2048 by 1536 pixels; FOV: 45 degrees: 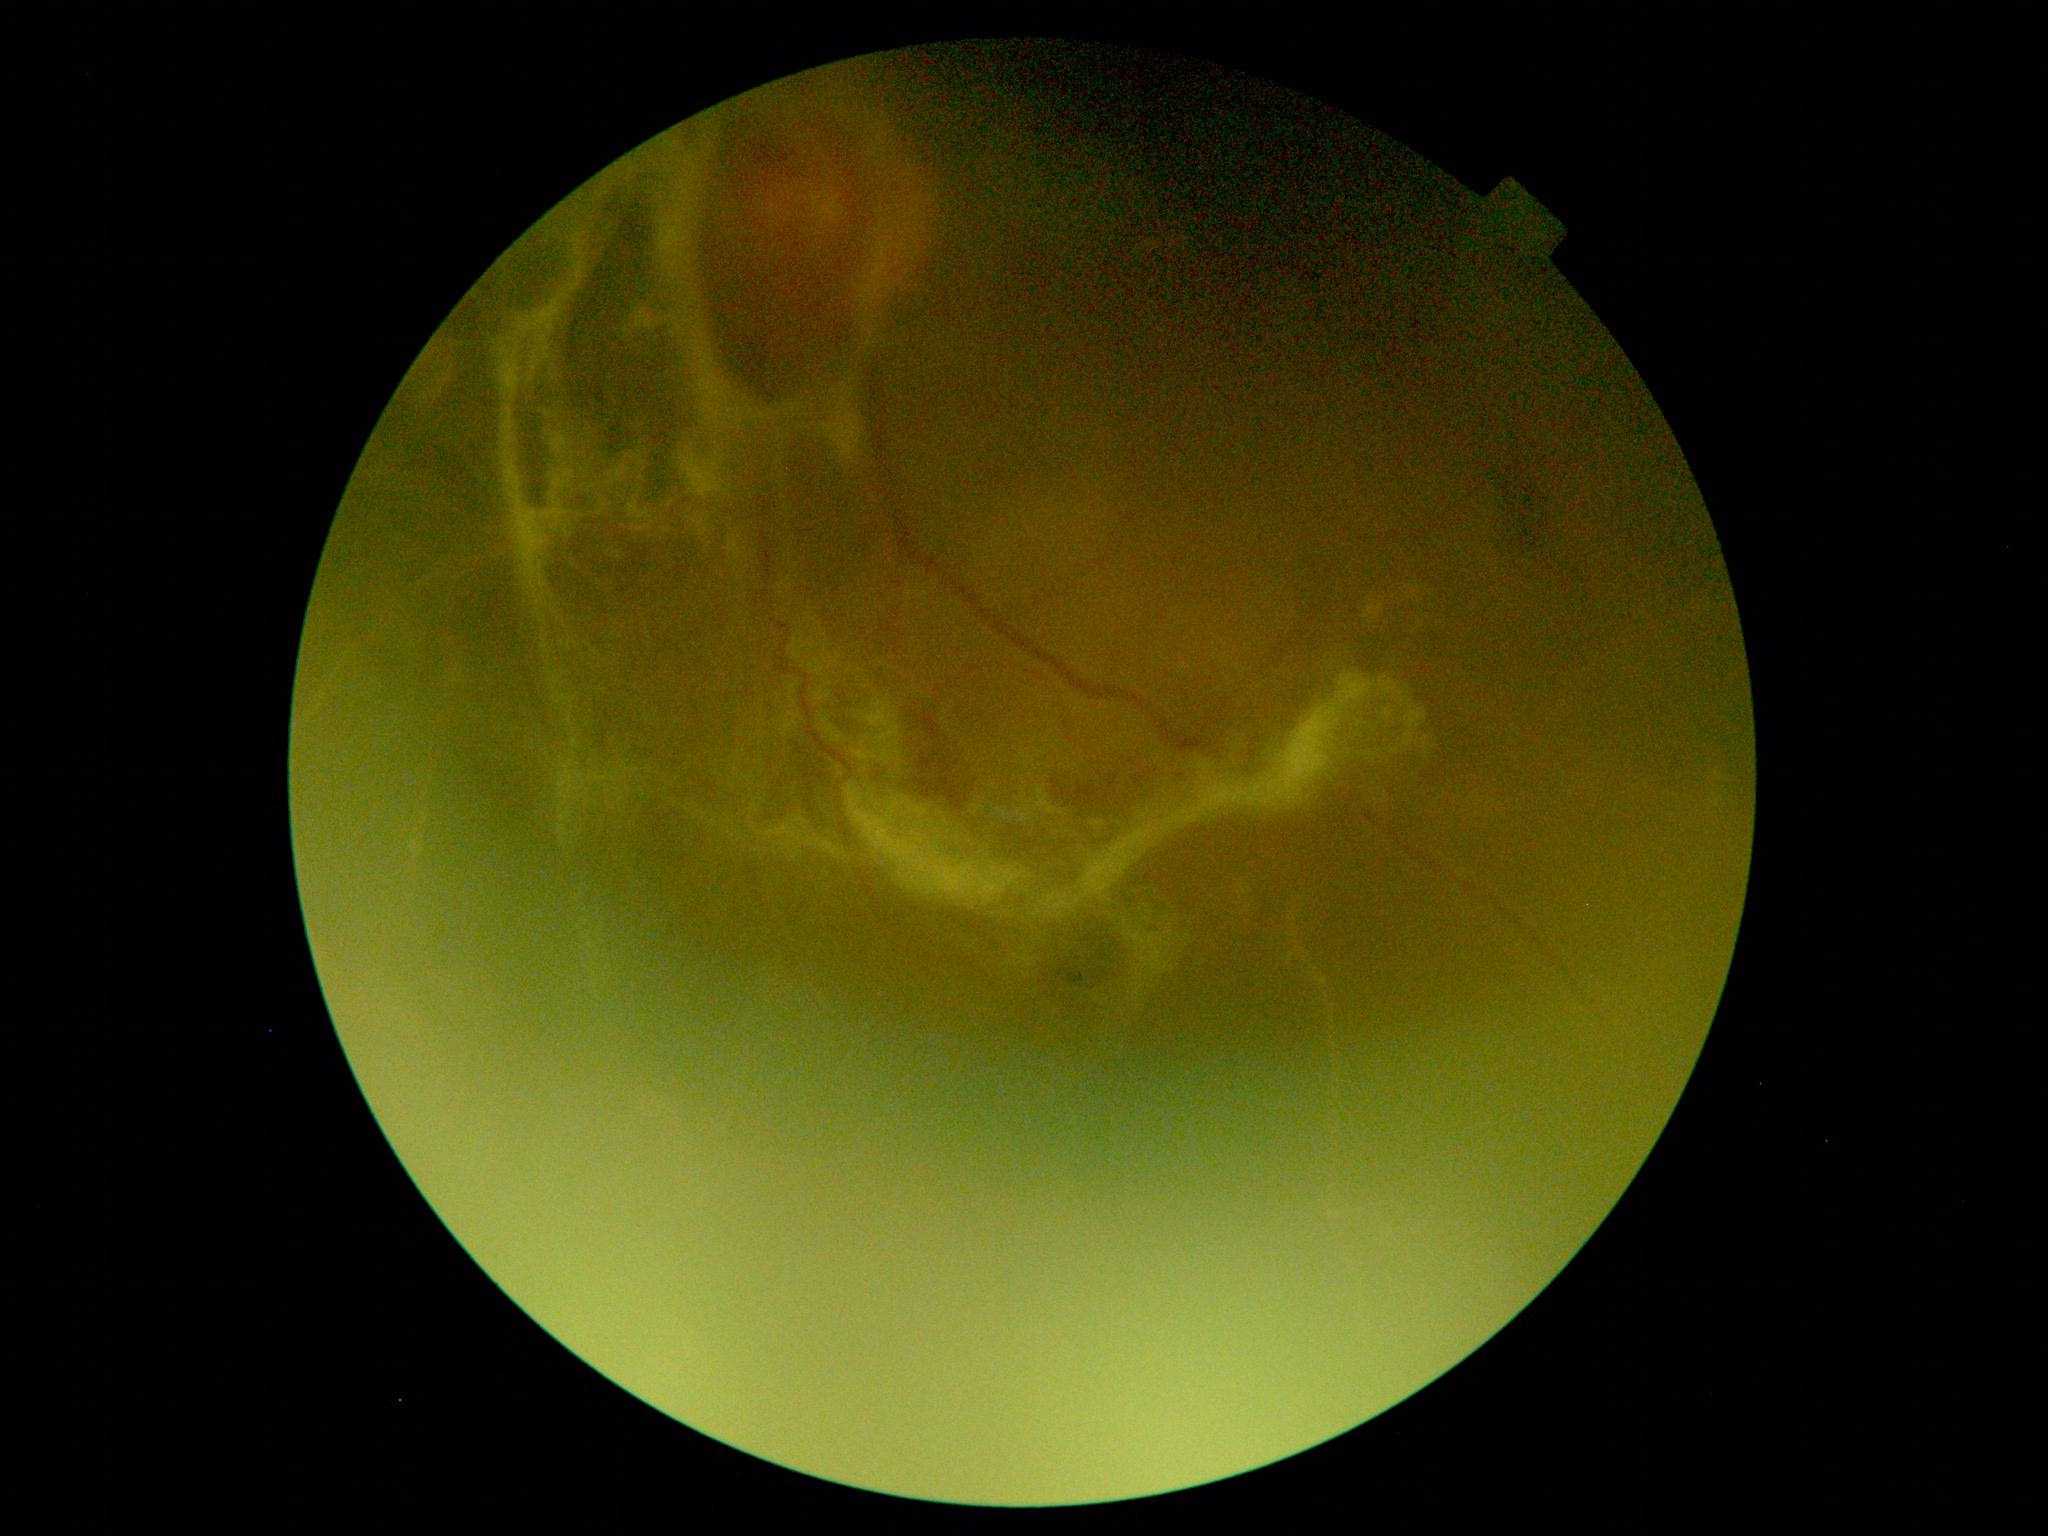

DR severity is 4/4.